Wide-field fundus image from infant ROP screening
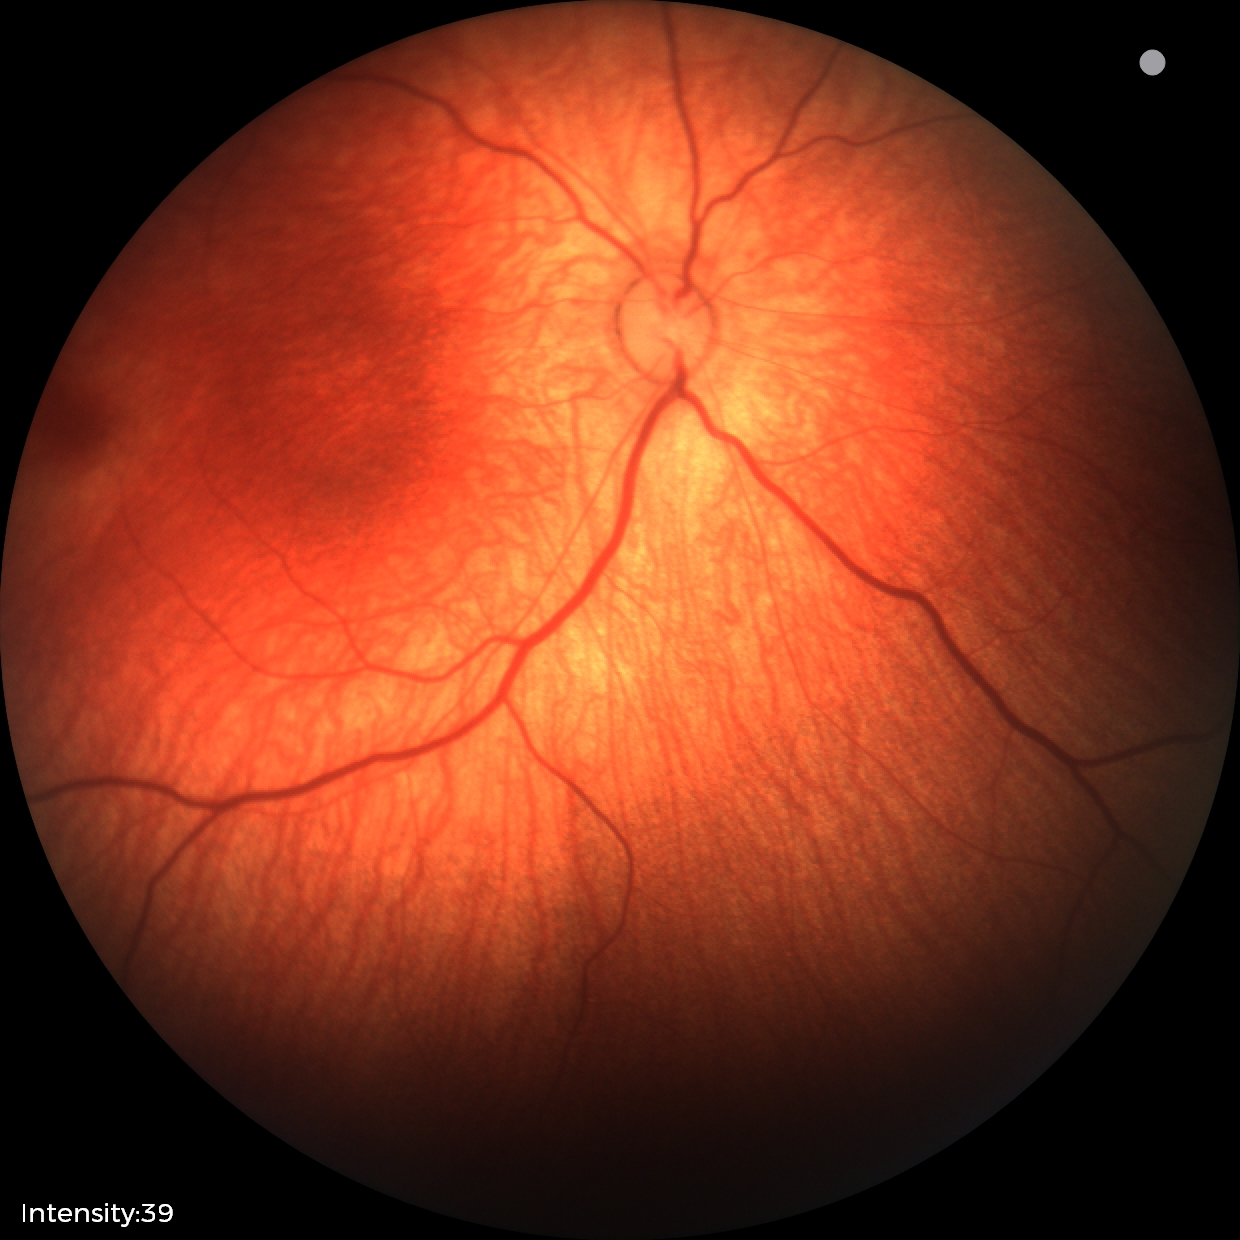
Screening diagnosis = normal.